45° field of view; 1536 x 1152 pixels; fundus photo: 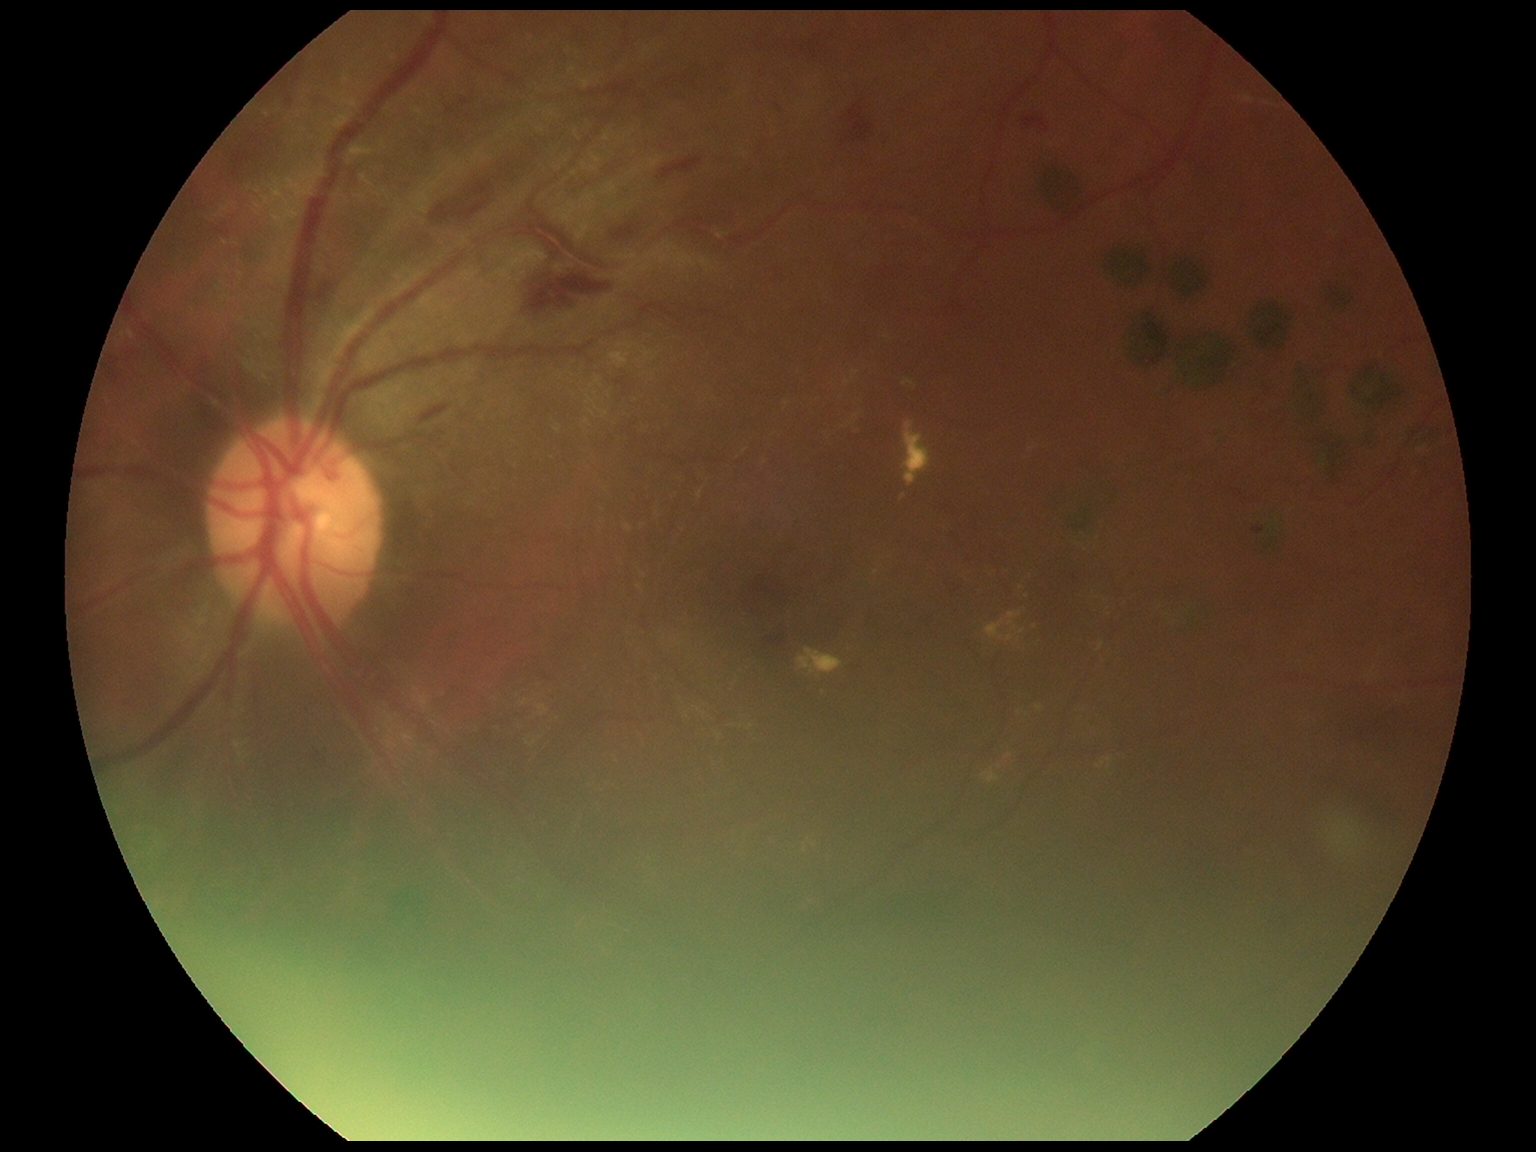
diabetic retinopathy: 2/4.